Graded on the modified Davis scale, without pupil dilation, 45 degree fundus photograph, image size 848x848.
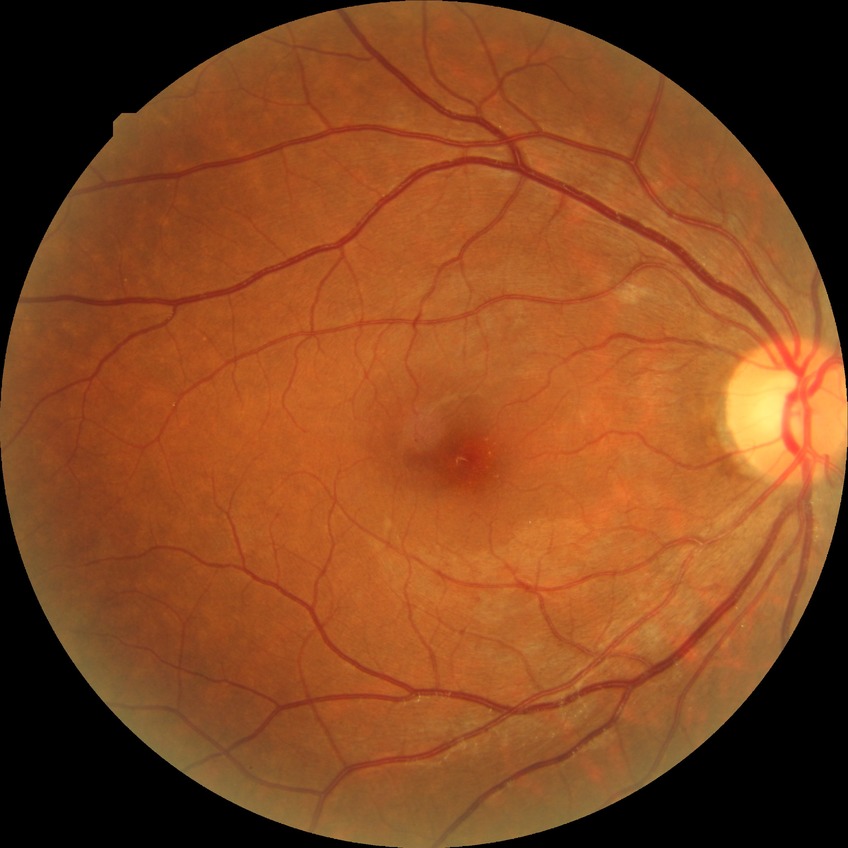 Diabetic retinopathy (DR): SDR (simple diabetic retinopathy).